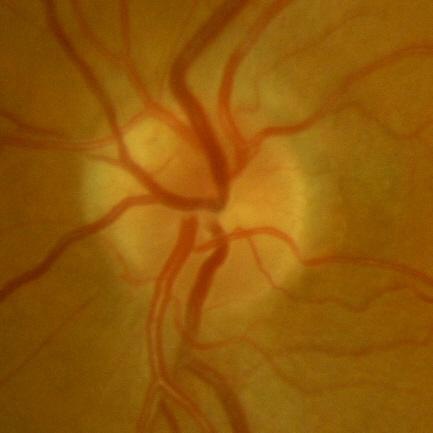

No glaucomatous damage.